Image size 512x512. Fundus photo — 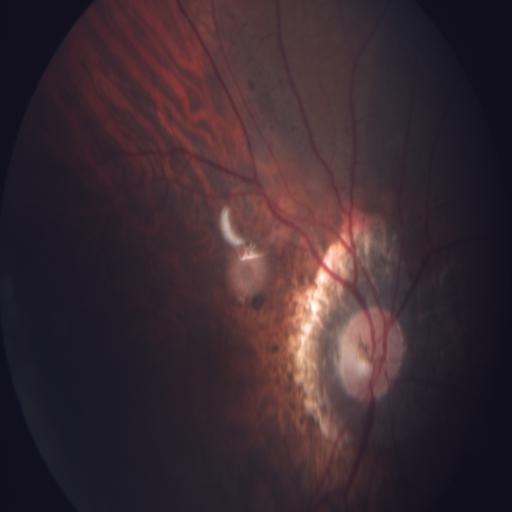
There is evidence of MYA (myopia).